Fundus photo. 2212x1659px — 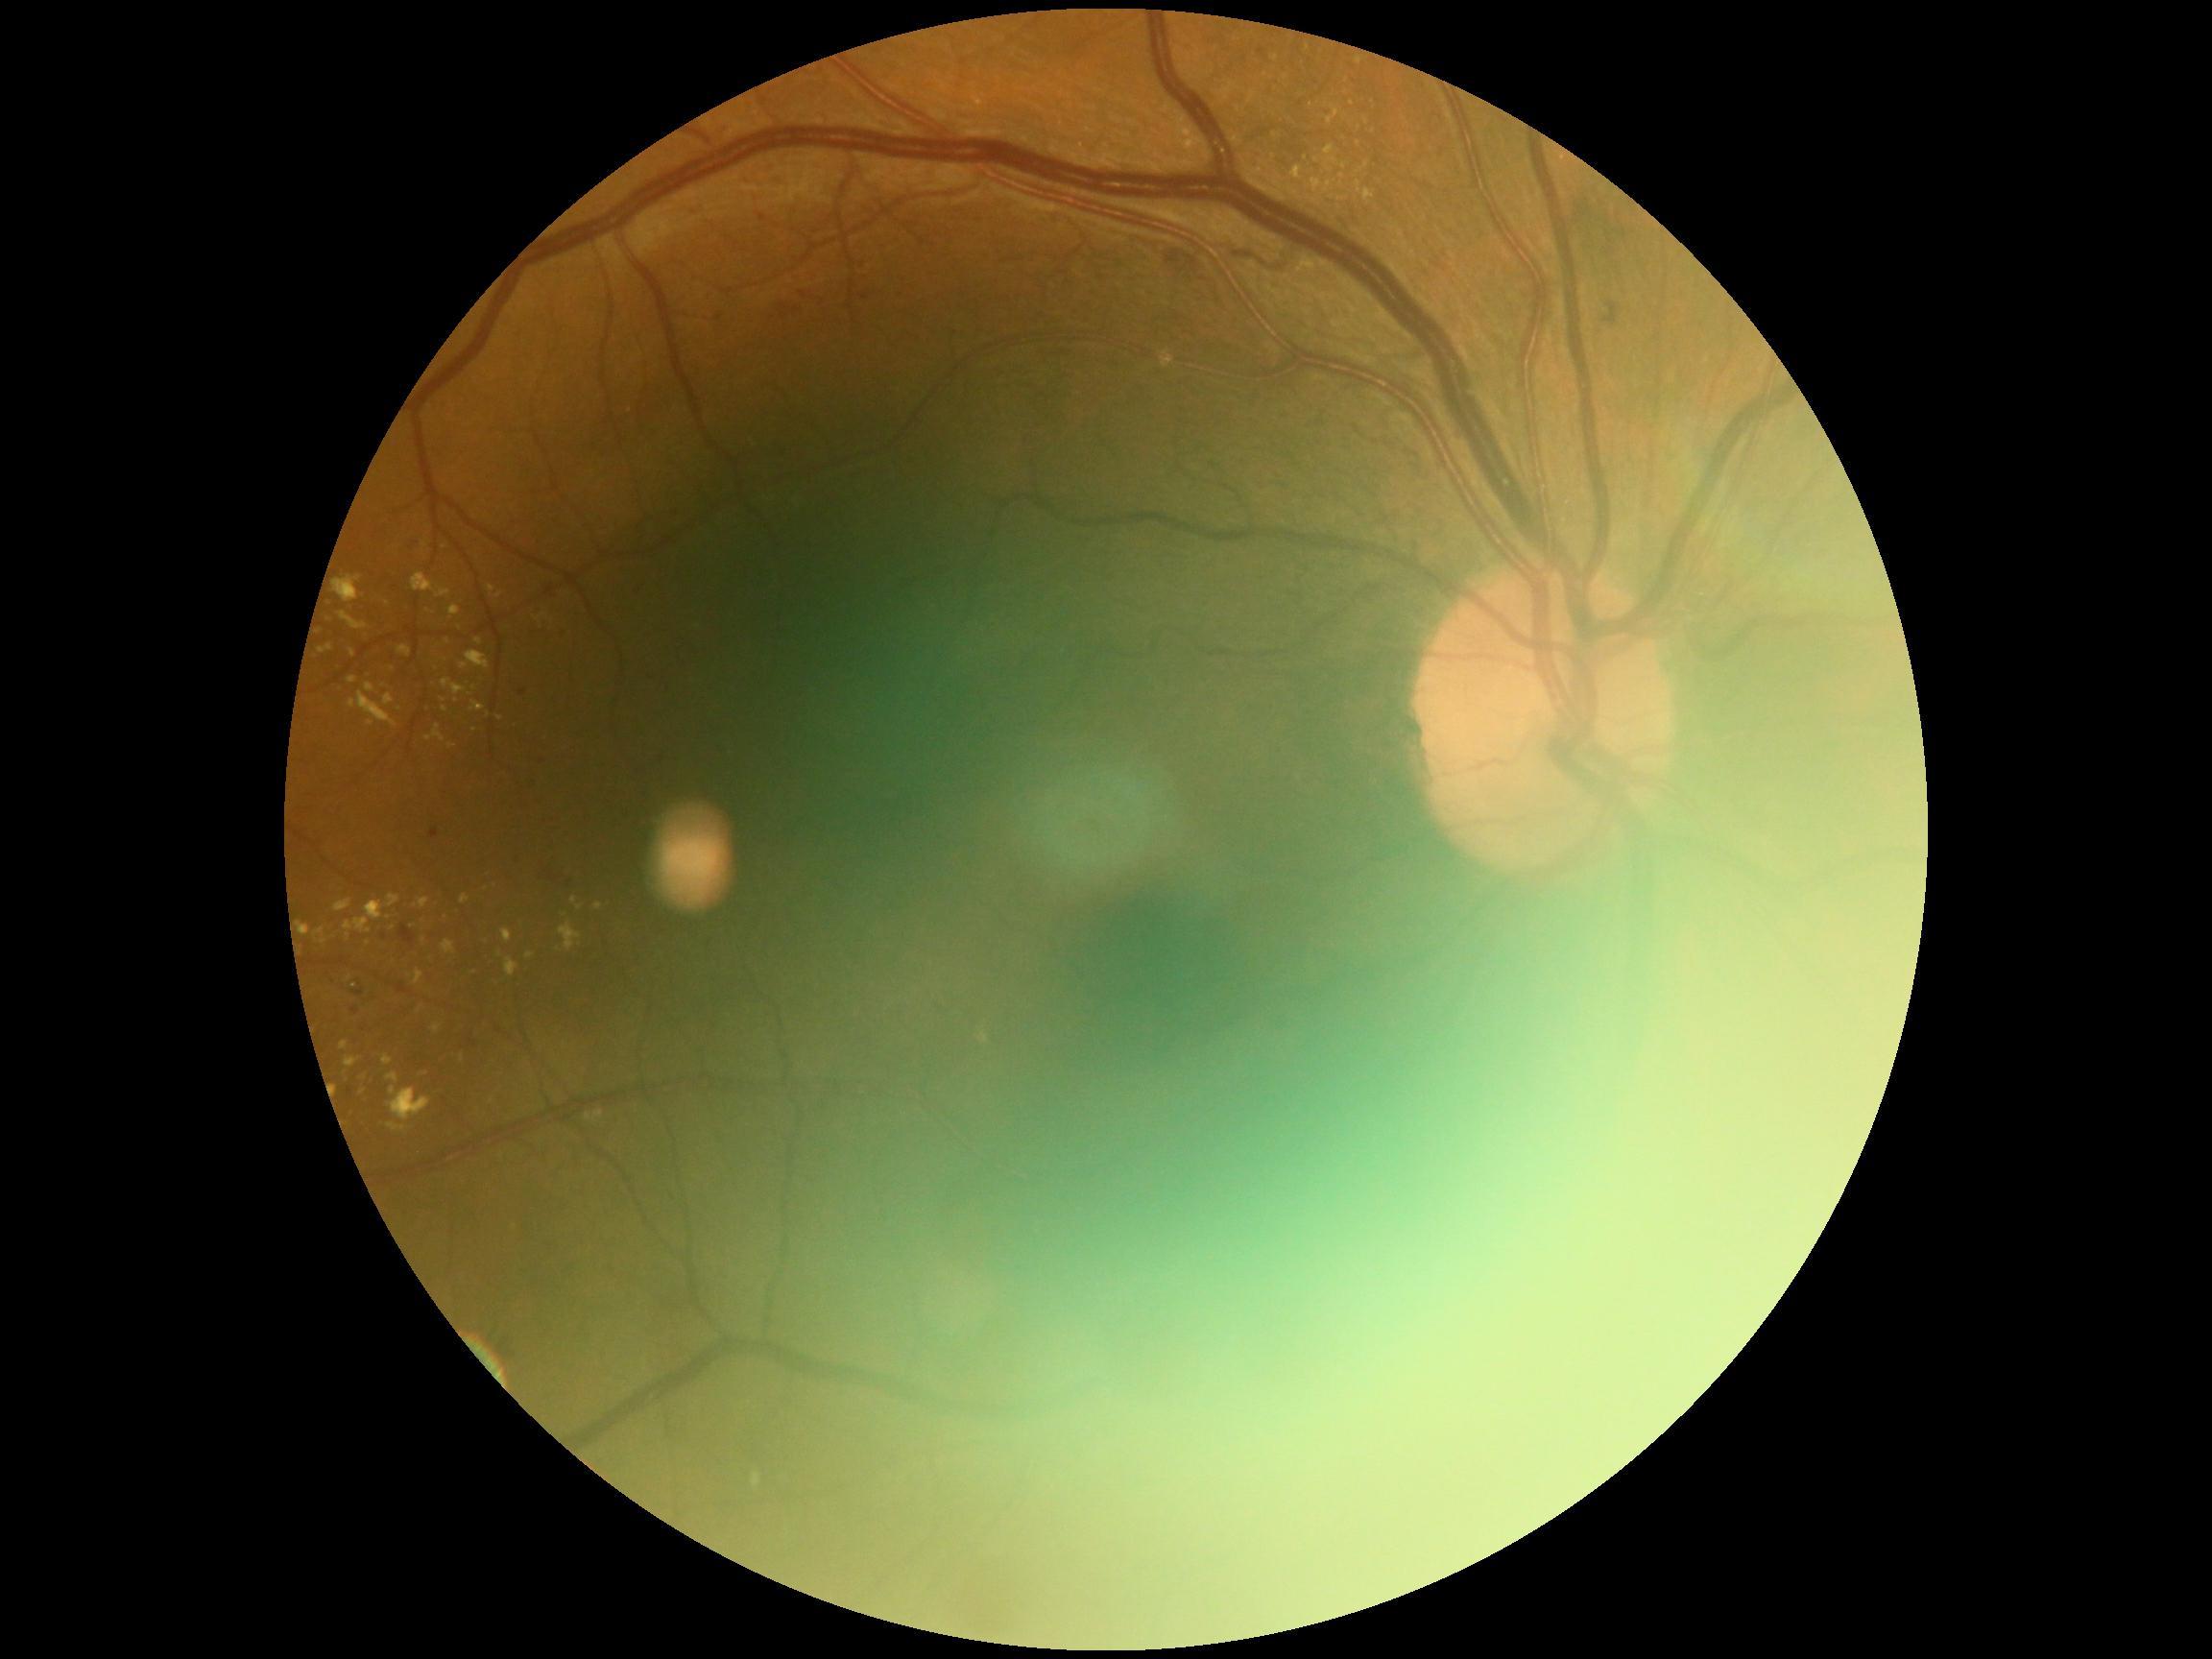 Diabetic retinopathy: moderate non-proliferative diabetic retinopathy (grade 2).
DR class: non-proliferative diabetic retinopathy.